Wide-field fundus photograph from neonatal ROP screening · 1440 x 1080 pixels — 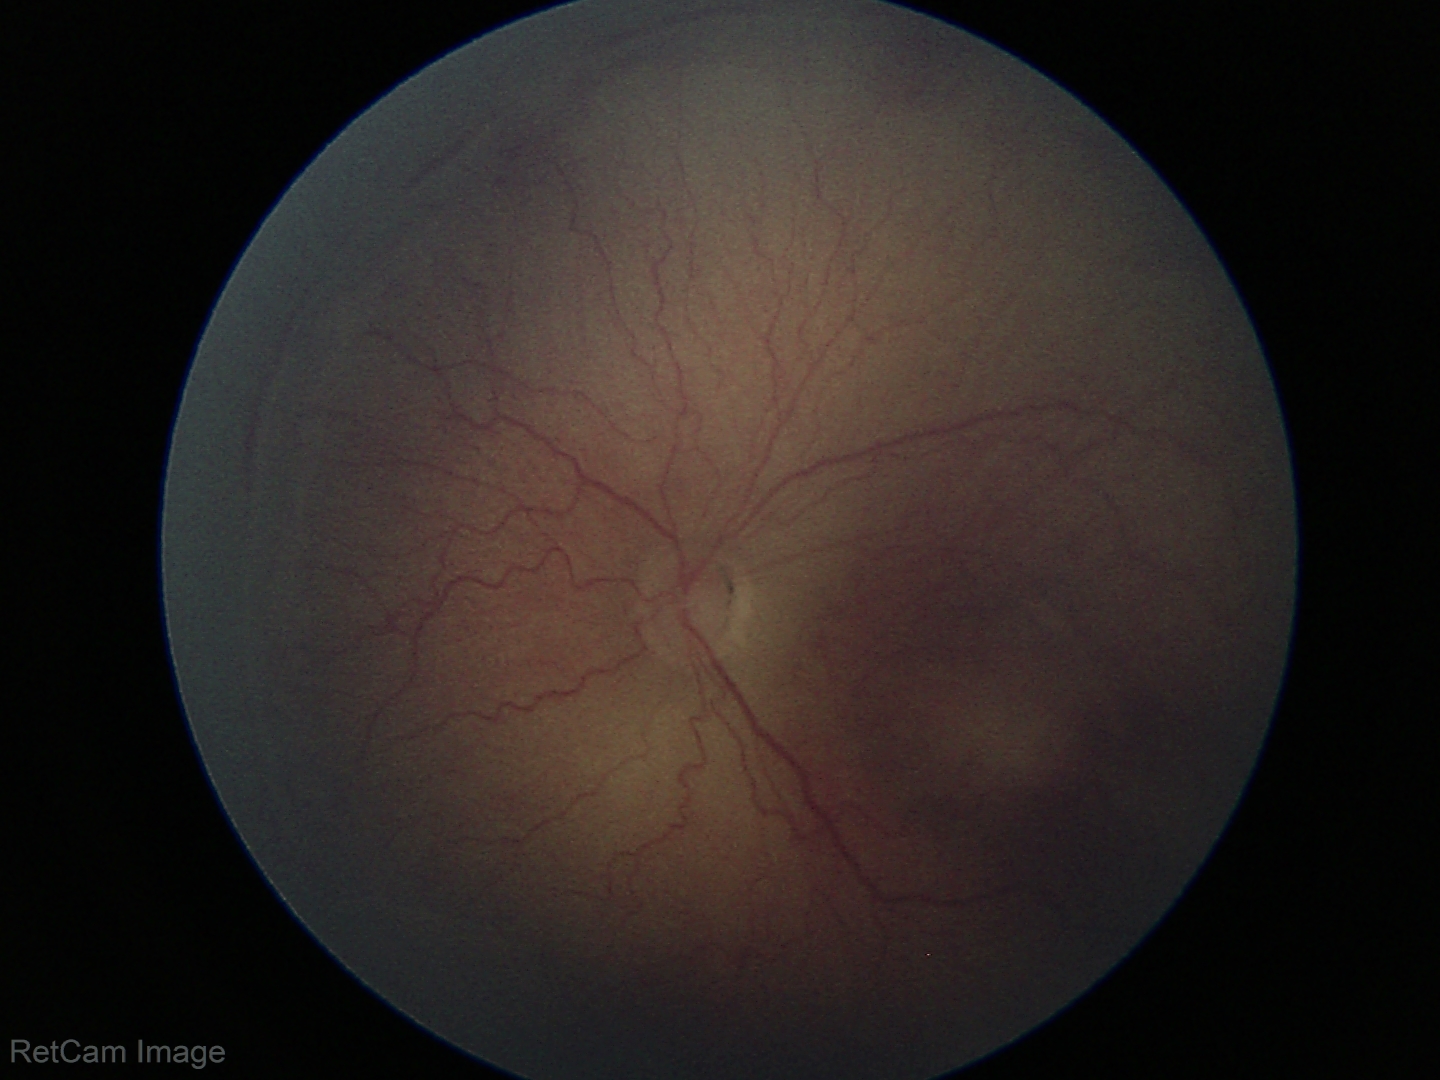 Plus disease absent. Diagnosis from this screening exam: retinopathy of prematurity (ROP) stage 2 — ridge with height and width at the demarcation line.